Ultra-widefield fundus photograph:
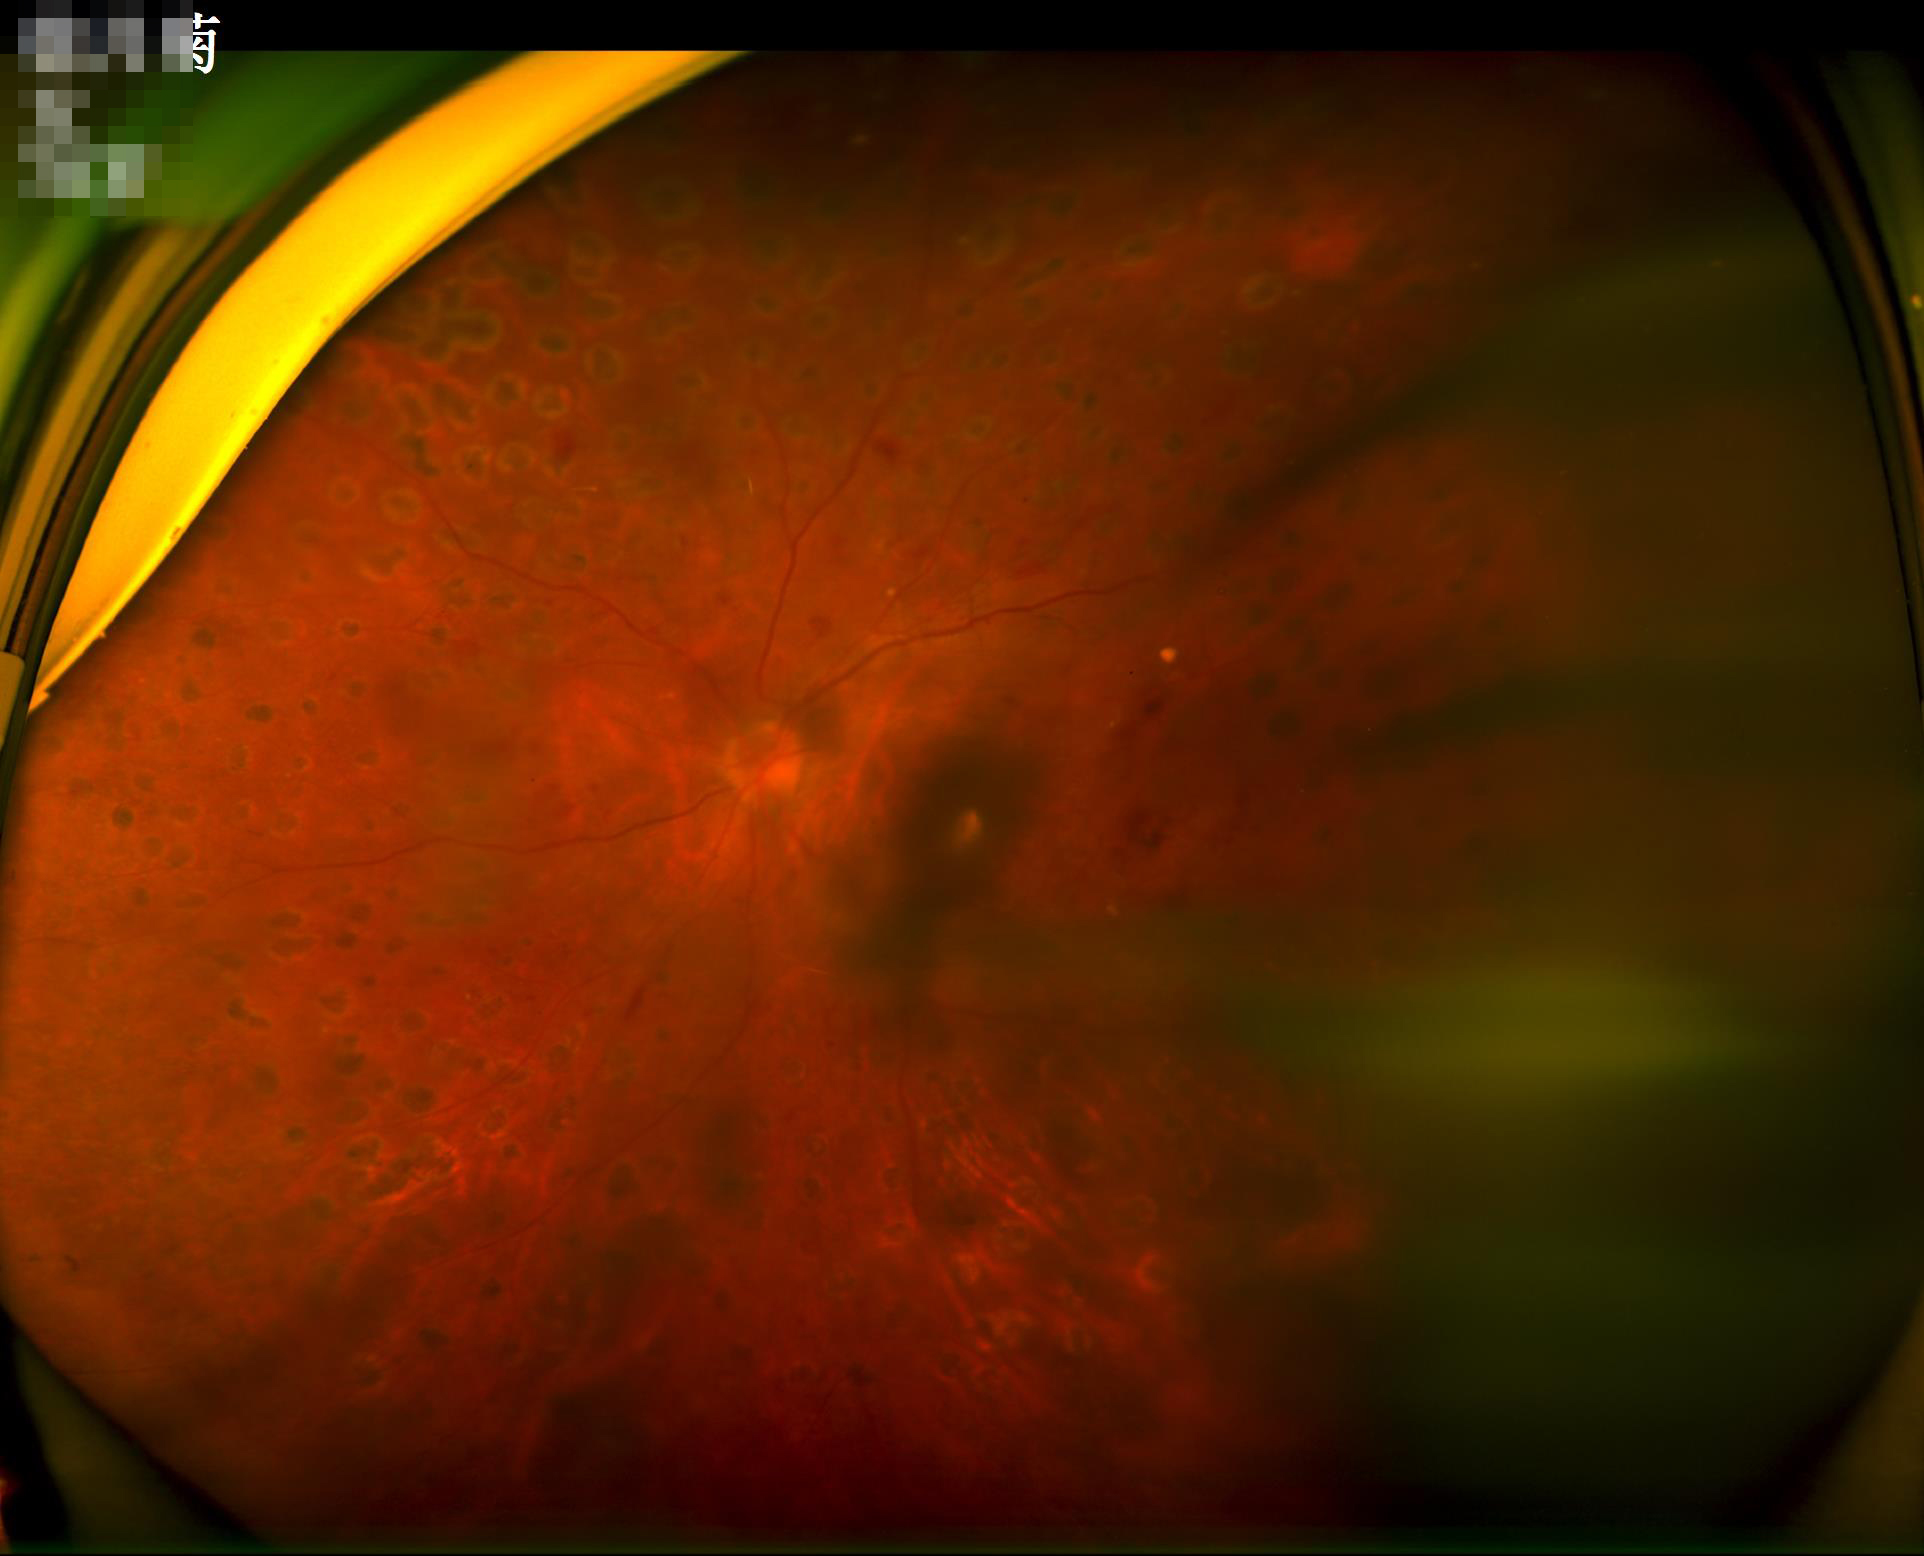
  contrast: good dynamic range
  clarity: optic disc, vessels, and background in focus
  overall_quality: poor and difficult to use diagnostically
  illumination: over- or under-exposed